Retinal fundus photograph. Camera: NIDEK AFC-230:
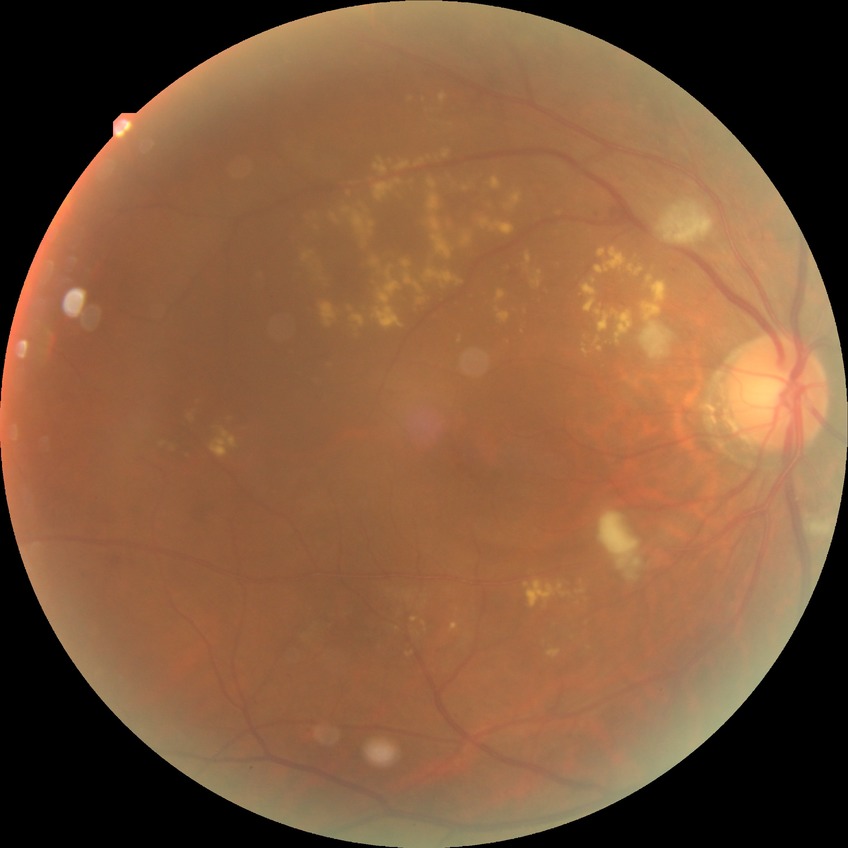
Diabetic retinopathy (DR): PPDR (pre-proliferative diabetic retinopathy). Disease class: non-proliferative diabetic retinopathy.